NIDEK AFC-230
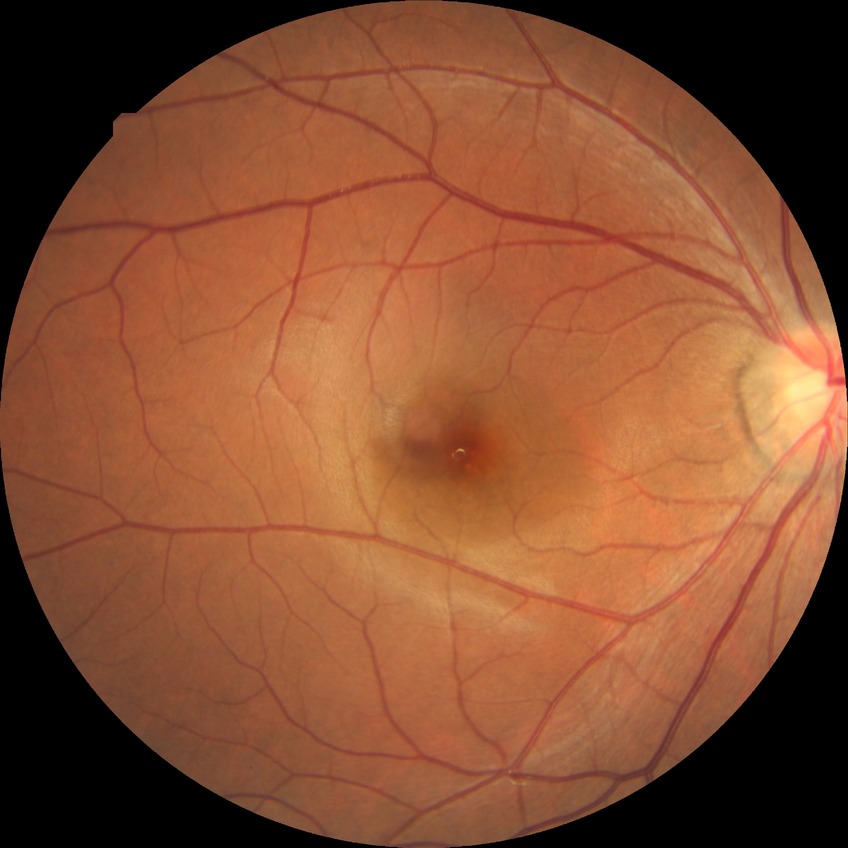 Annotations:
- modified Davis grading — no diabetic retinopathy